848x848px · posterior pole color fundus photograph.
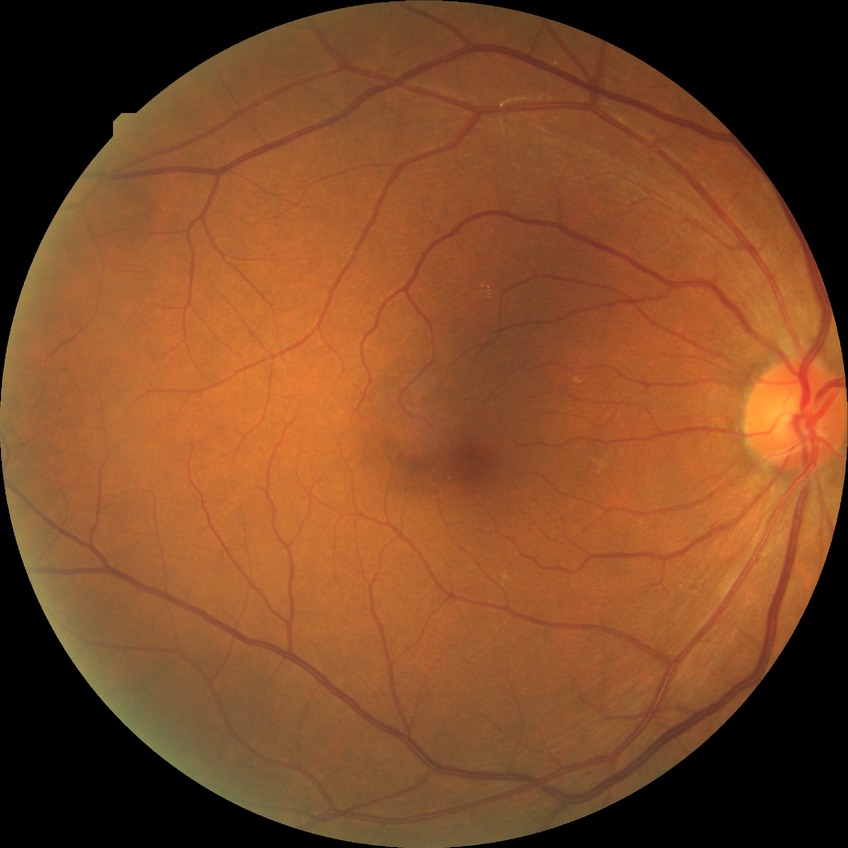

Davis stage is SDR. The retinopathy is classified as non-proliferative diabetic retinopathy.